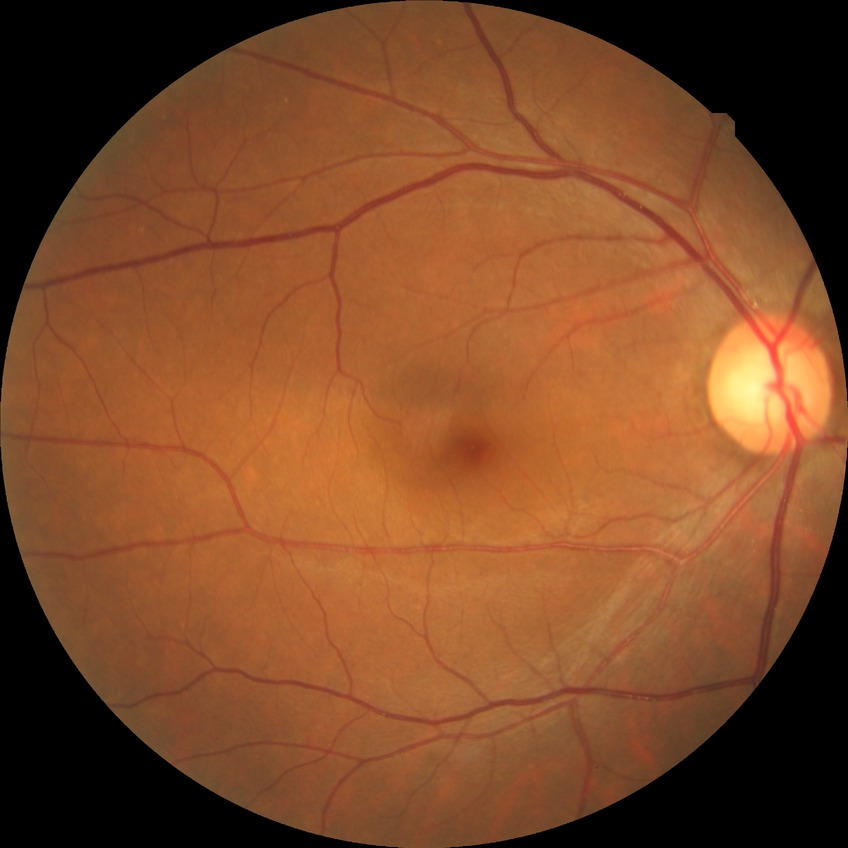

Davis grade: NDR. No signs of diabetic retinopathy.